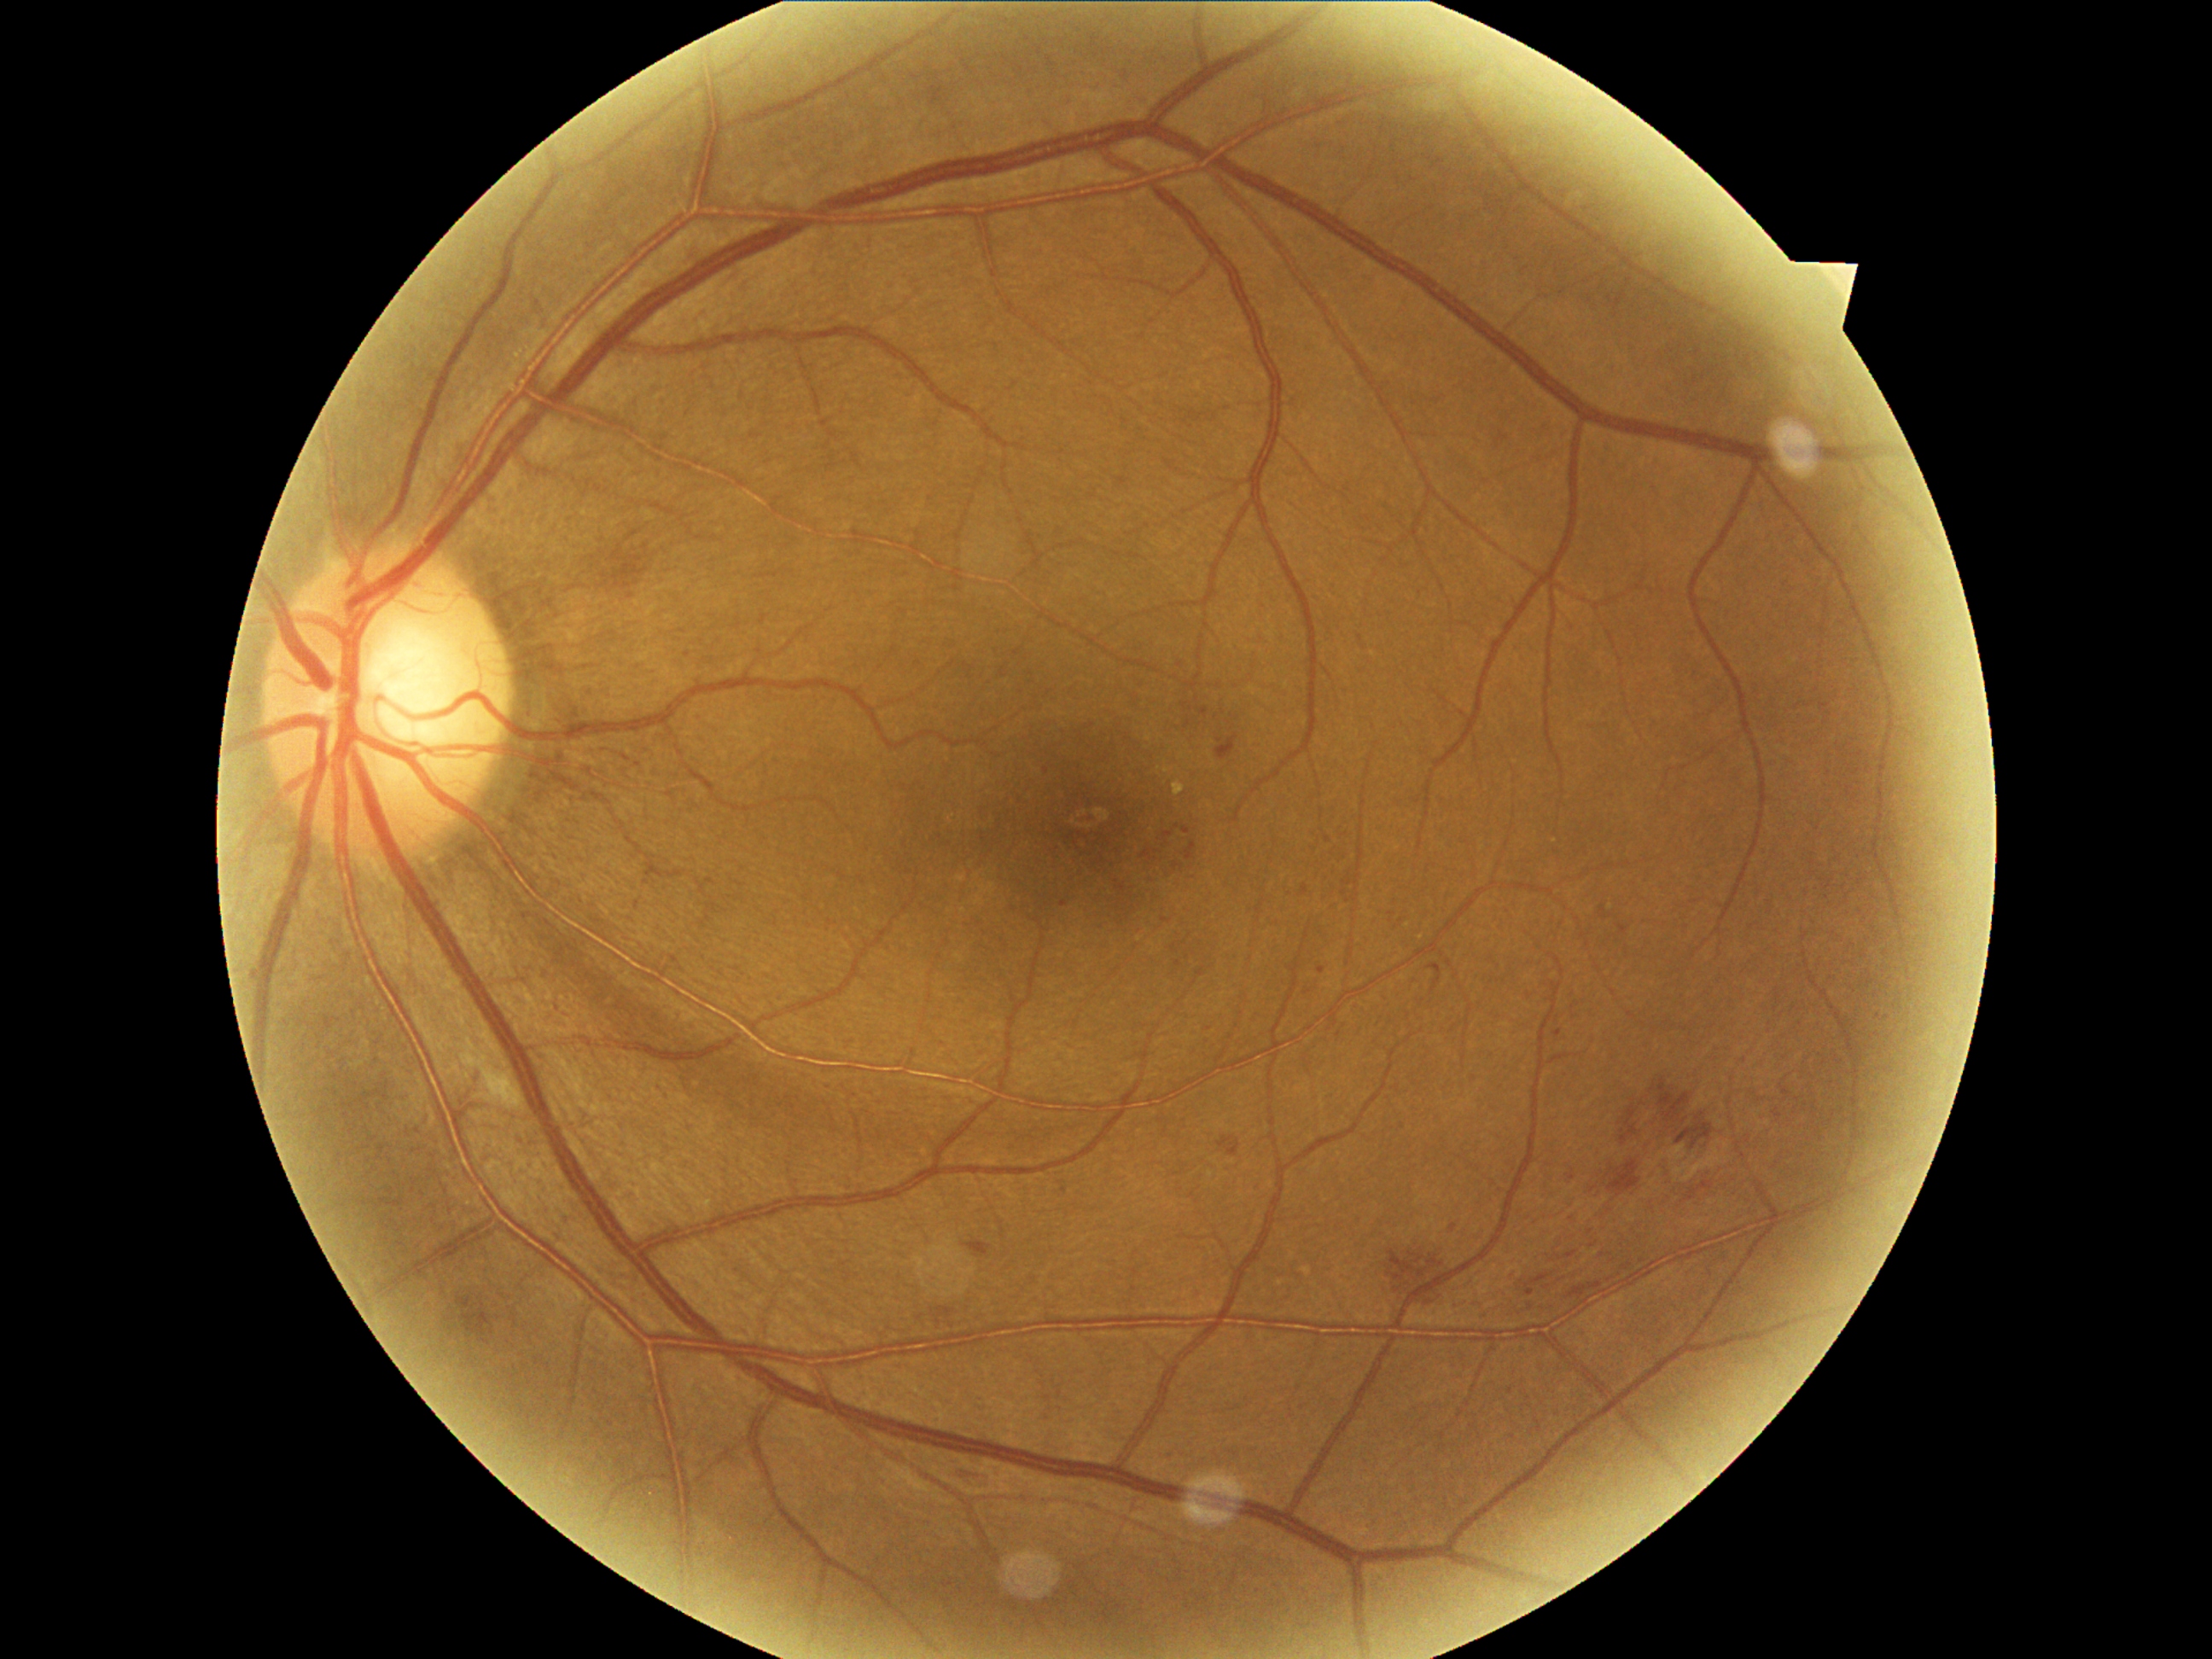

Disease class: non-proliferative diabetic retinopathy.
Retinopathy is moderate non-proliferative diabetic retinopathy (grade 2).